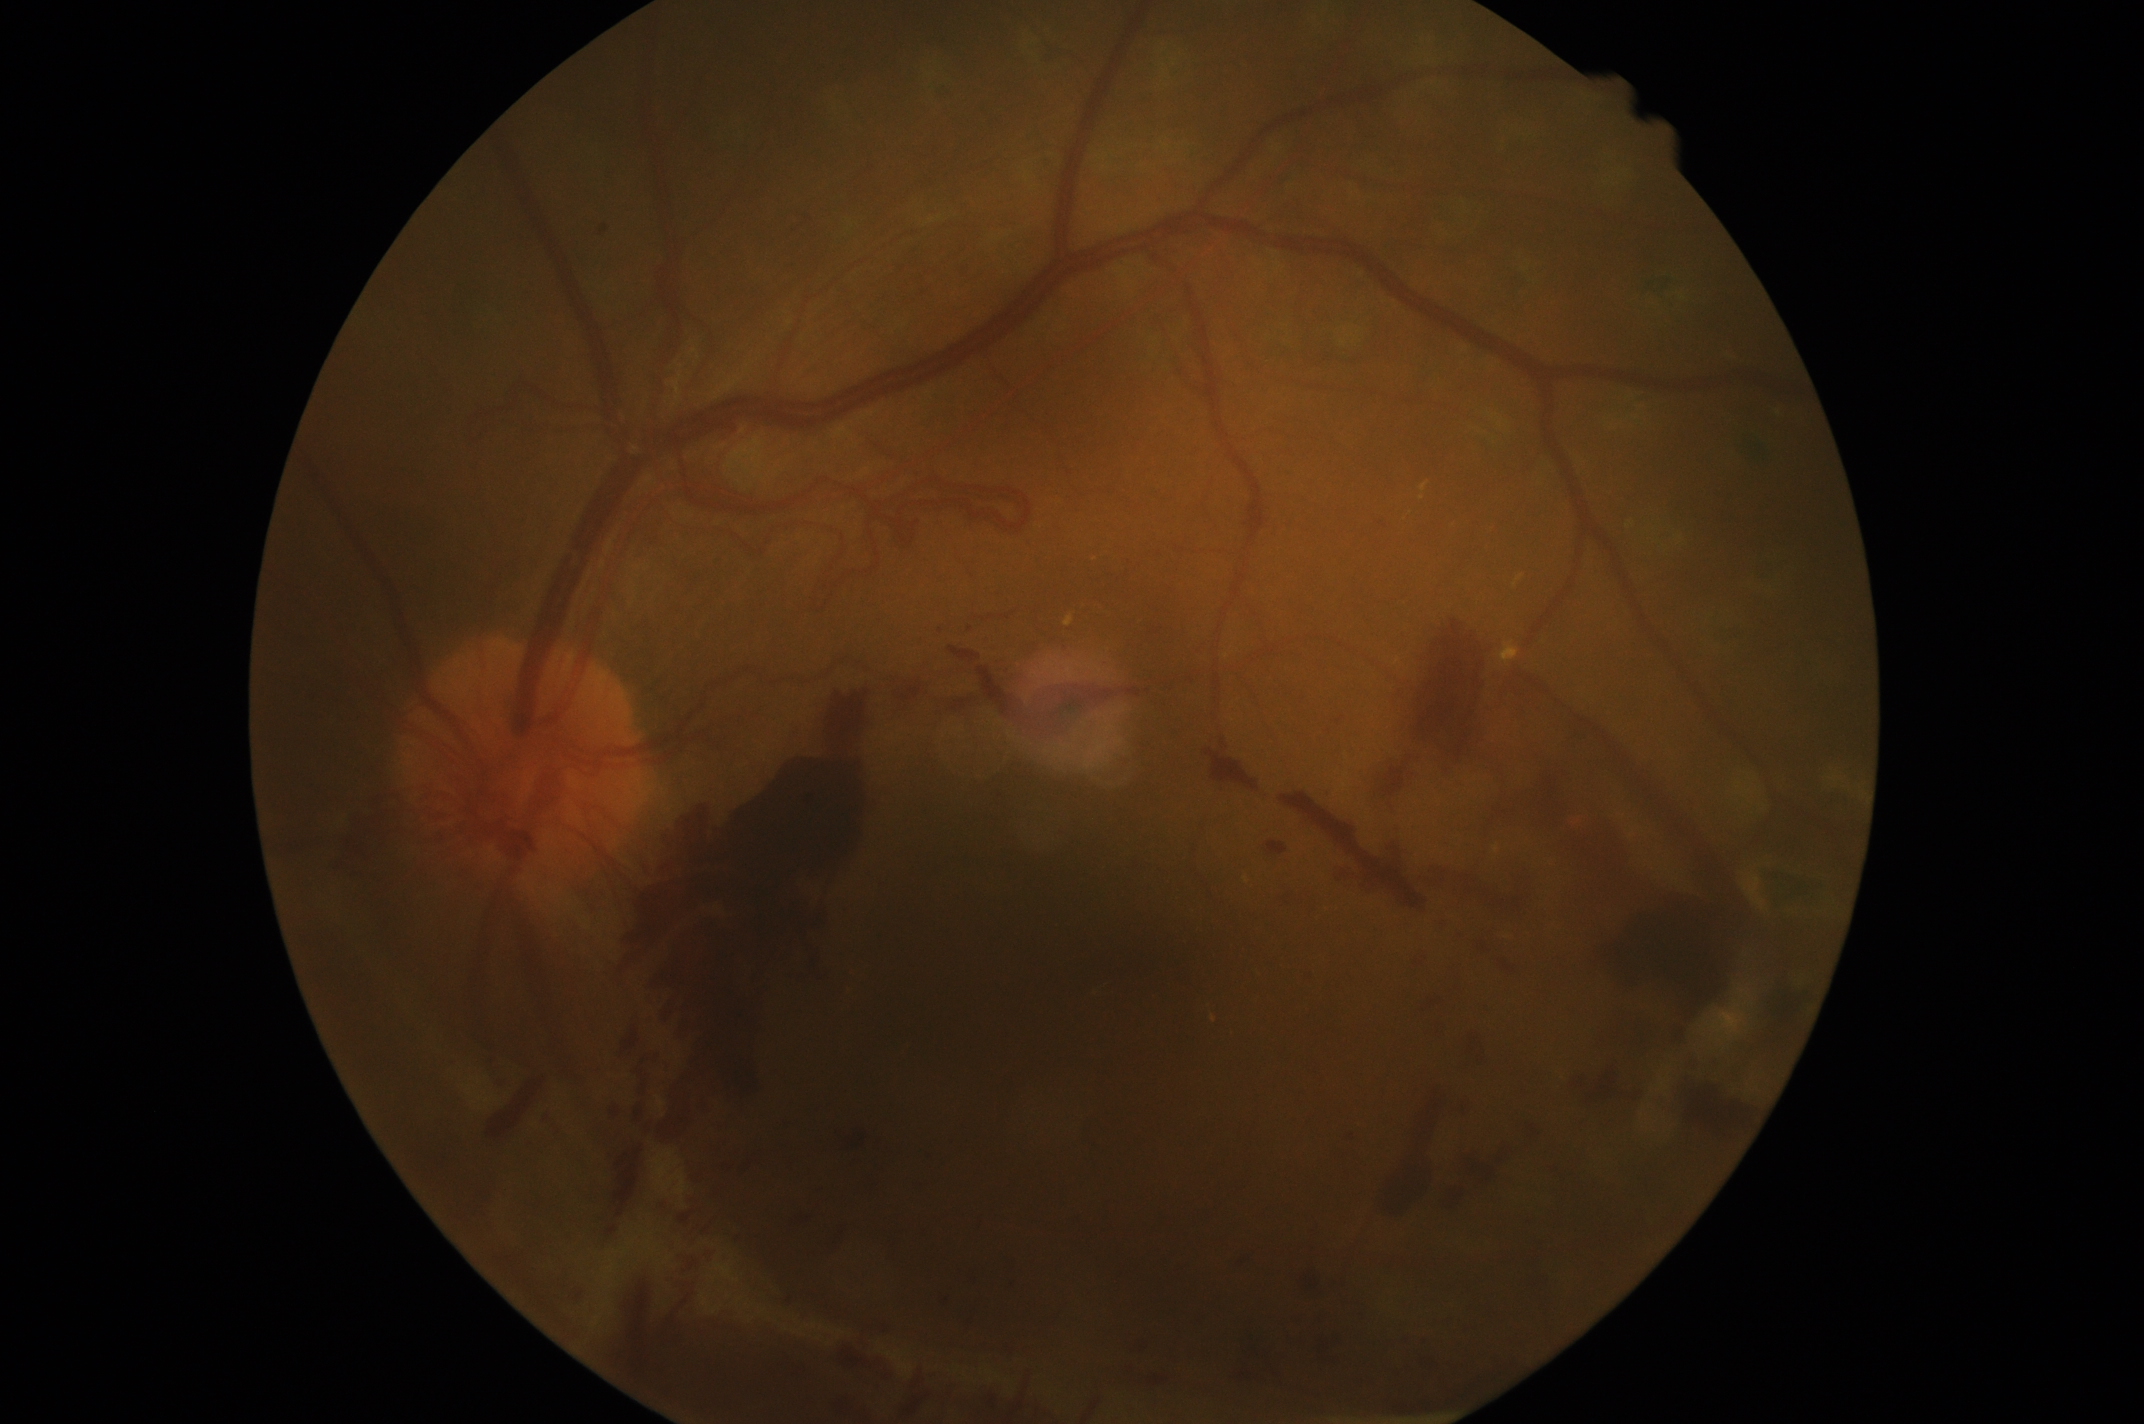

Annotations:
• diabetic retinopathy (DR): grade 4 (PDR) — neovascularization and/or vitreous/pre-retinal hemorrhage